2212x1659px. 45° FOV. Color fundus photograph: 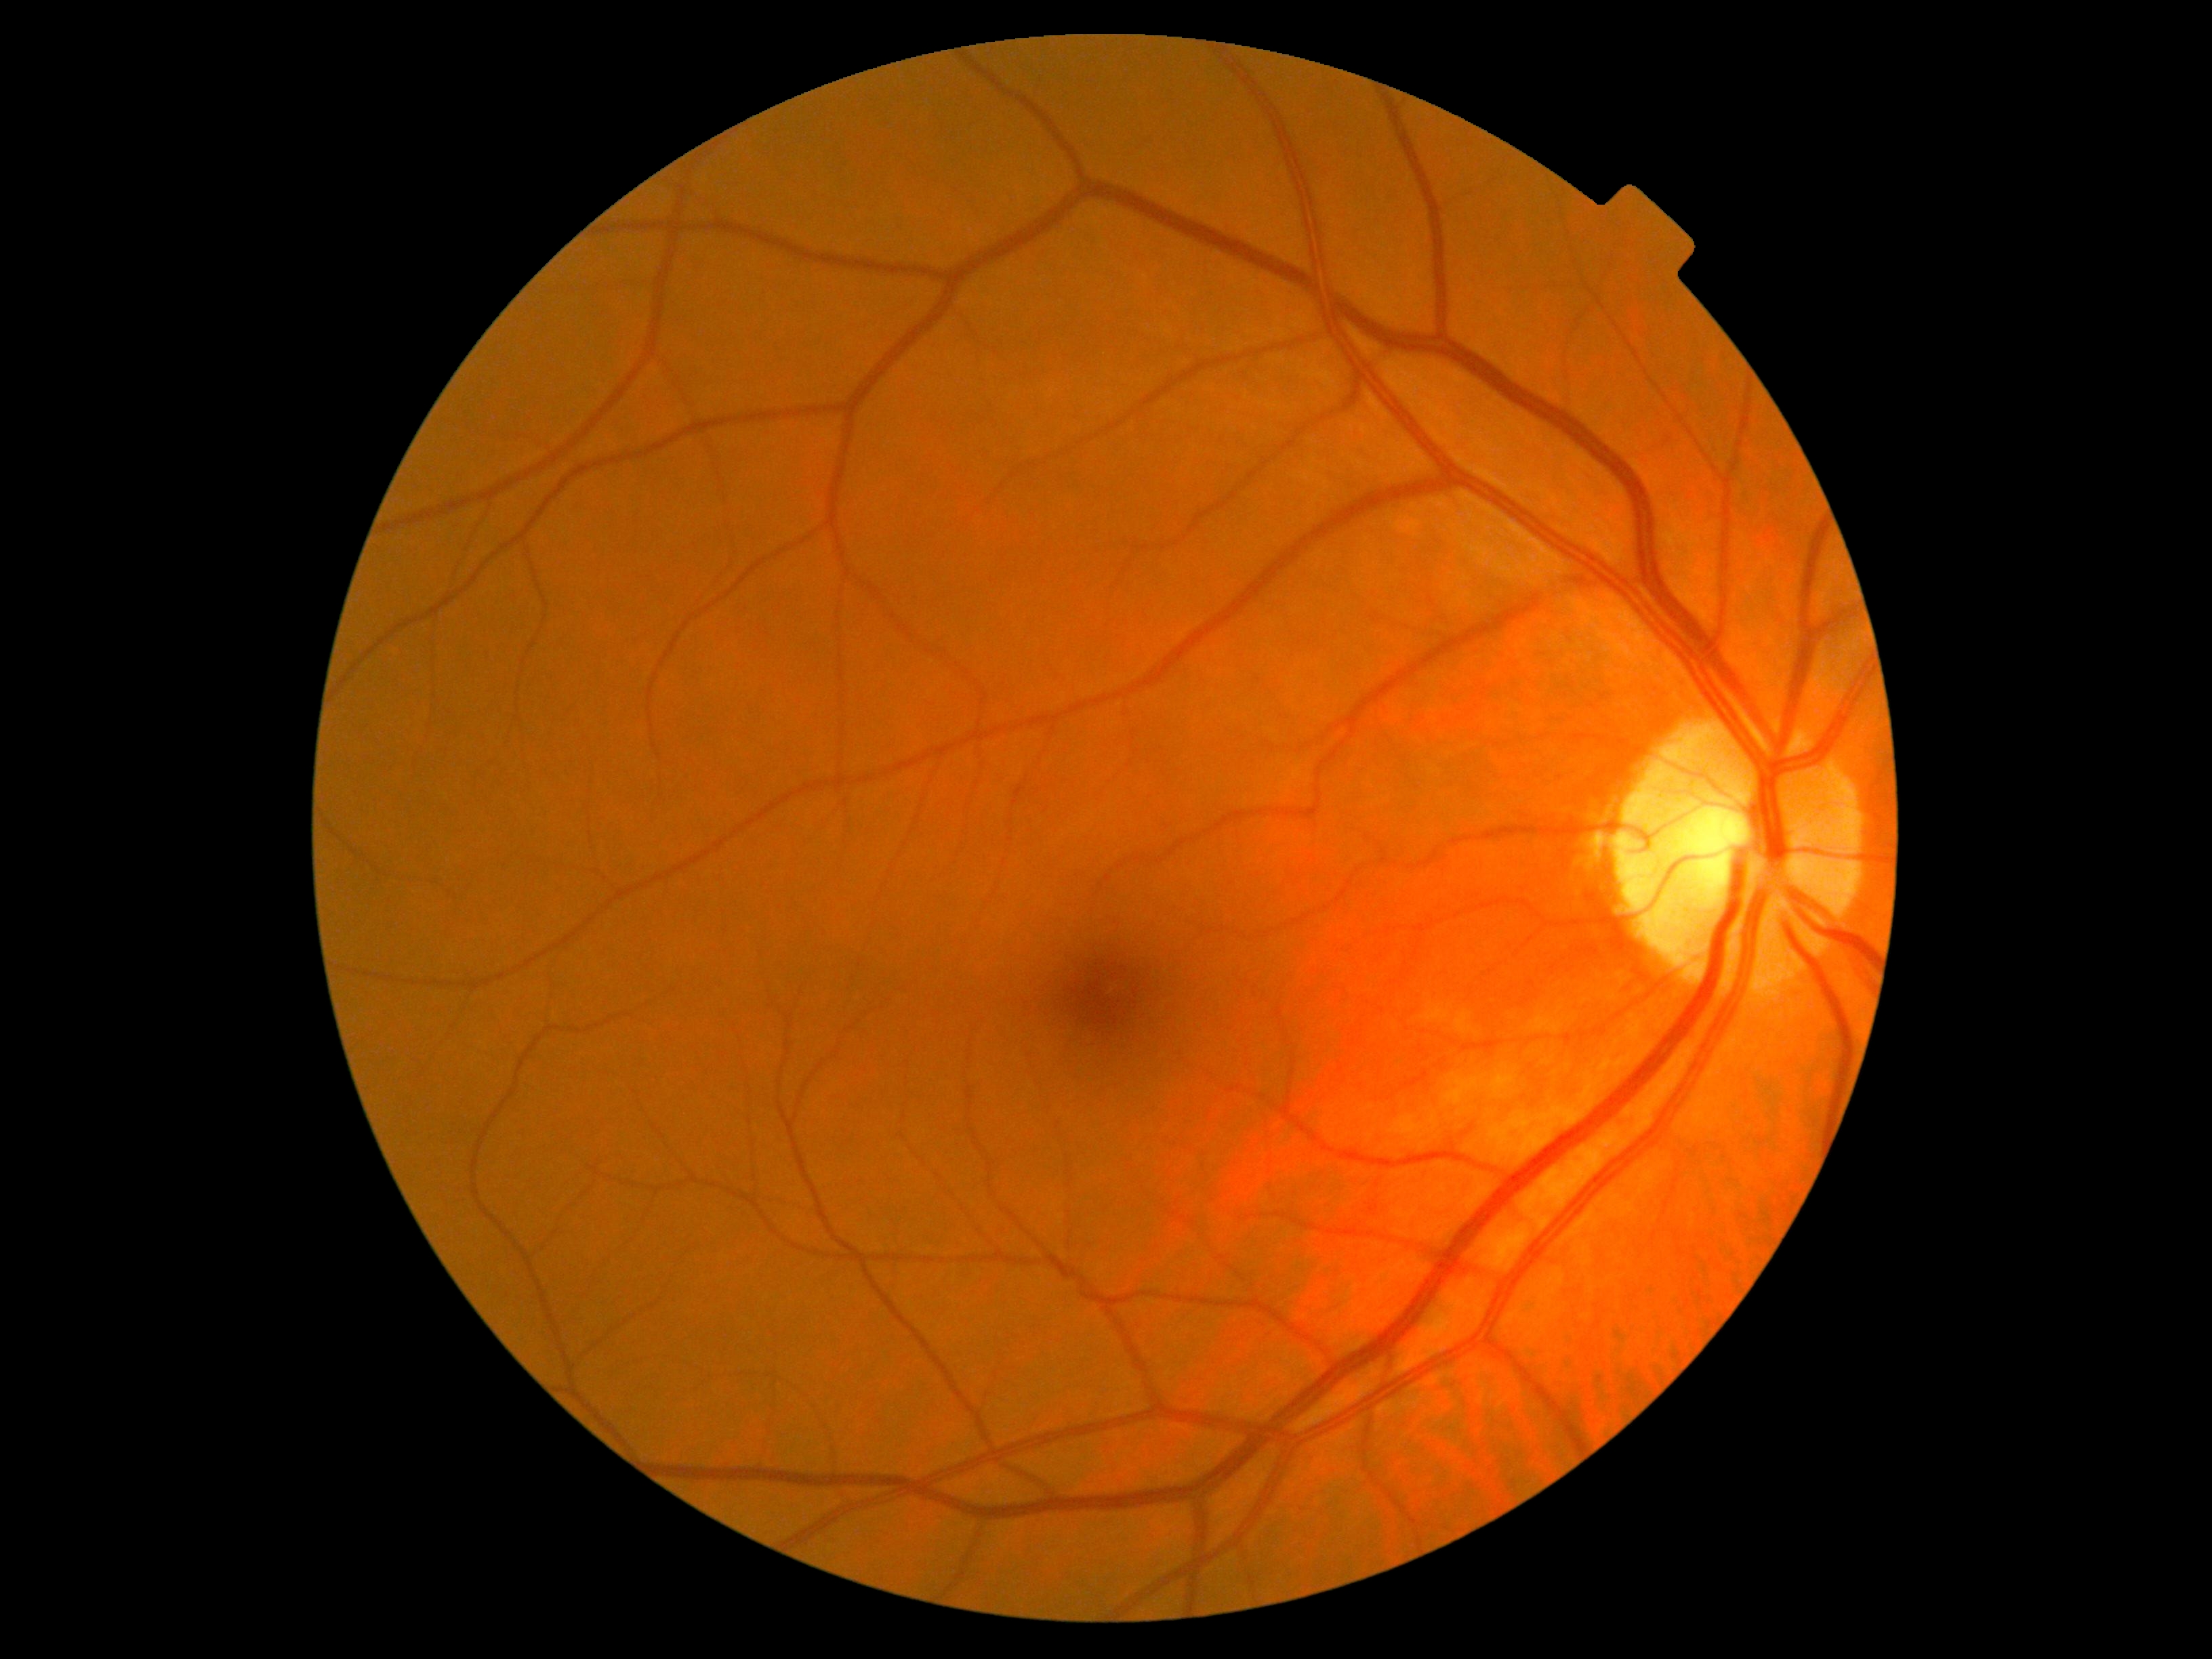
Retinopathy grade: 0/4.